Pachymetry: 522 µm: 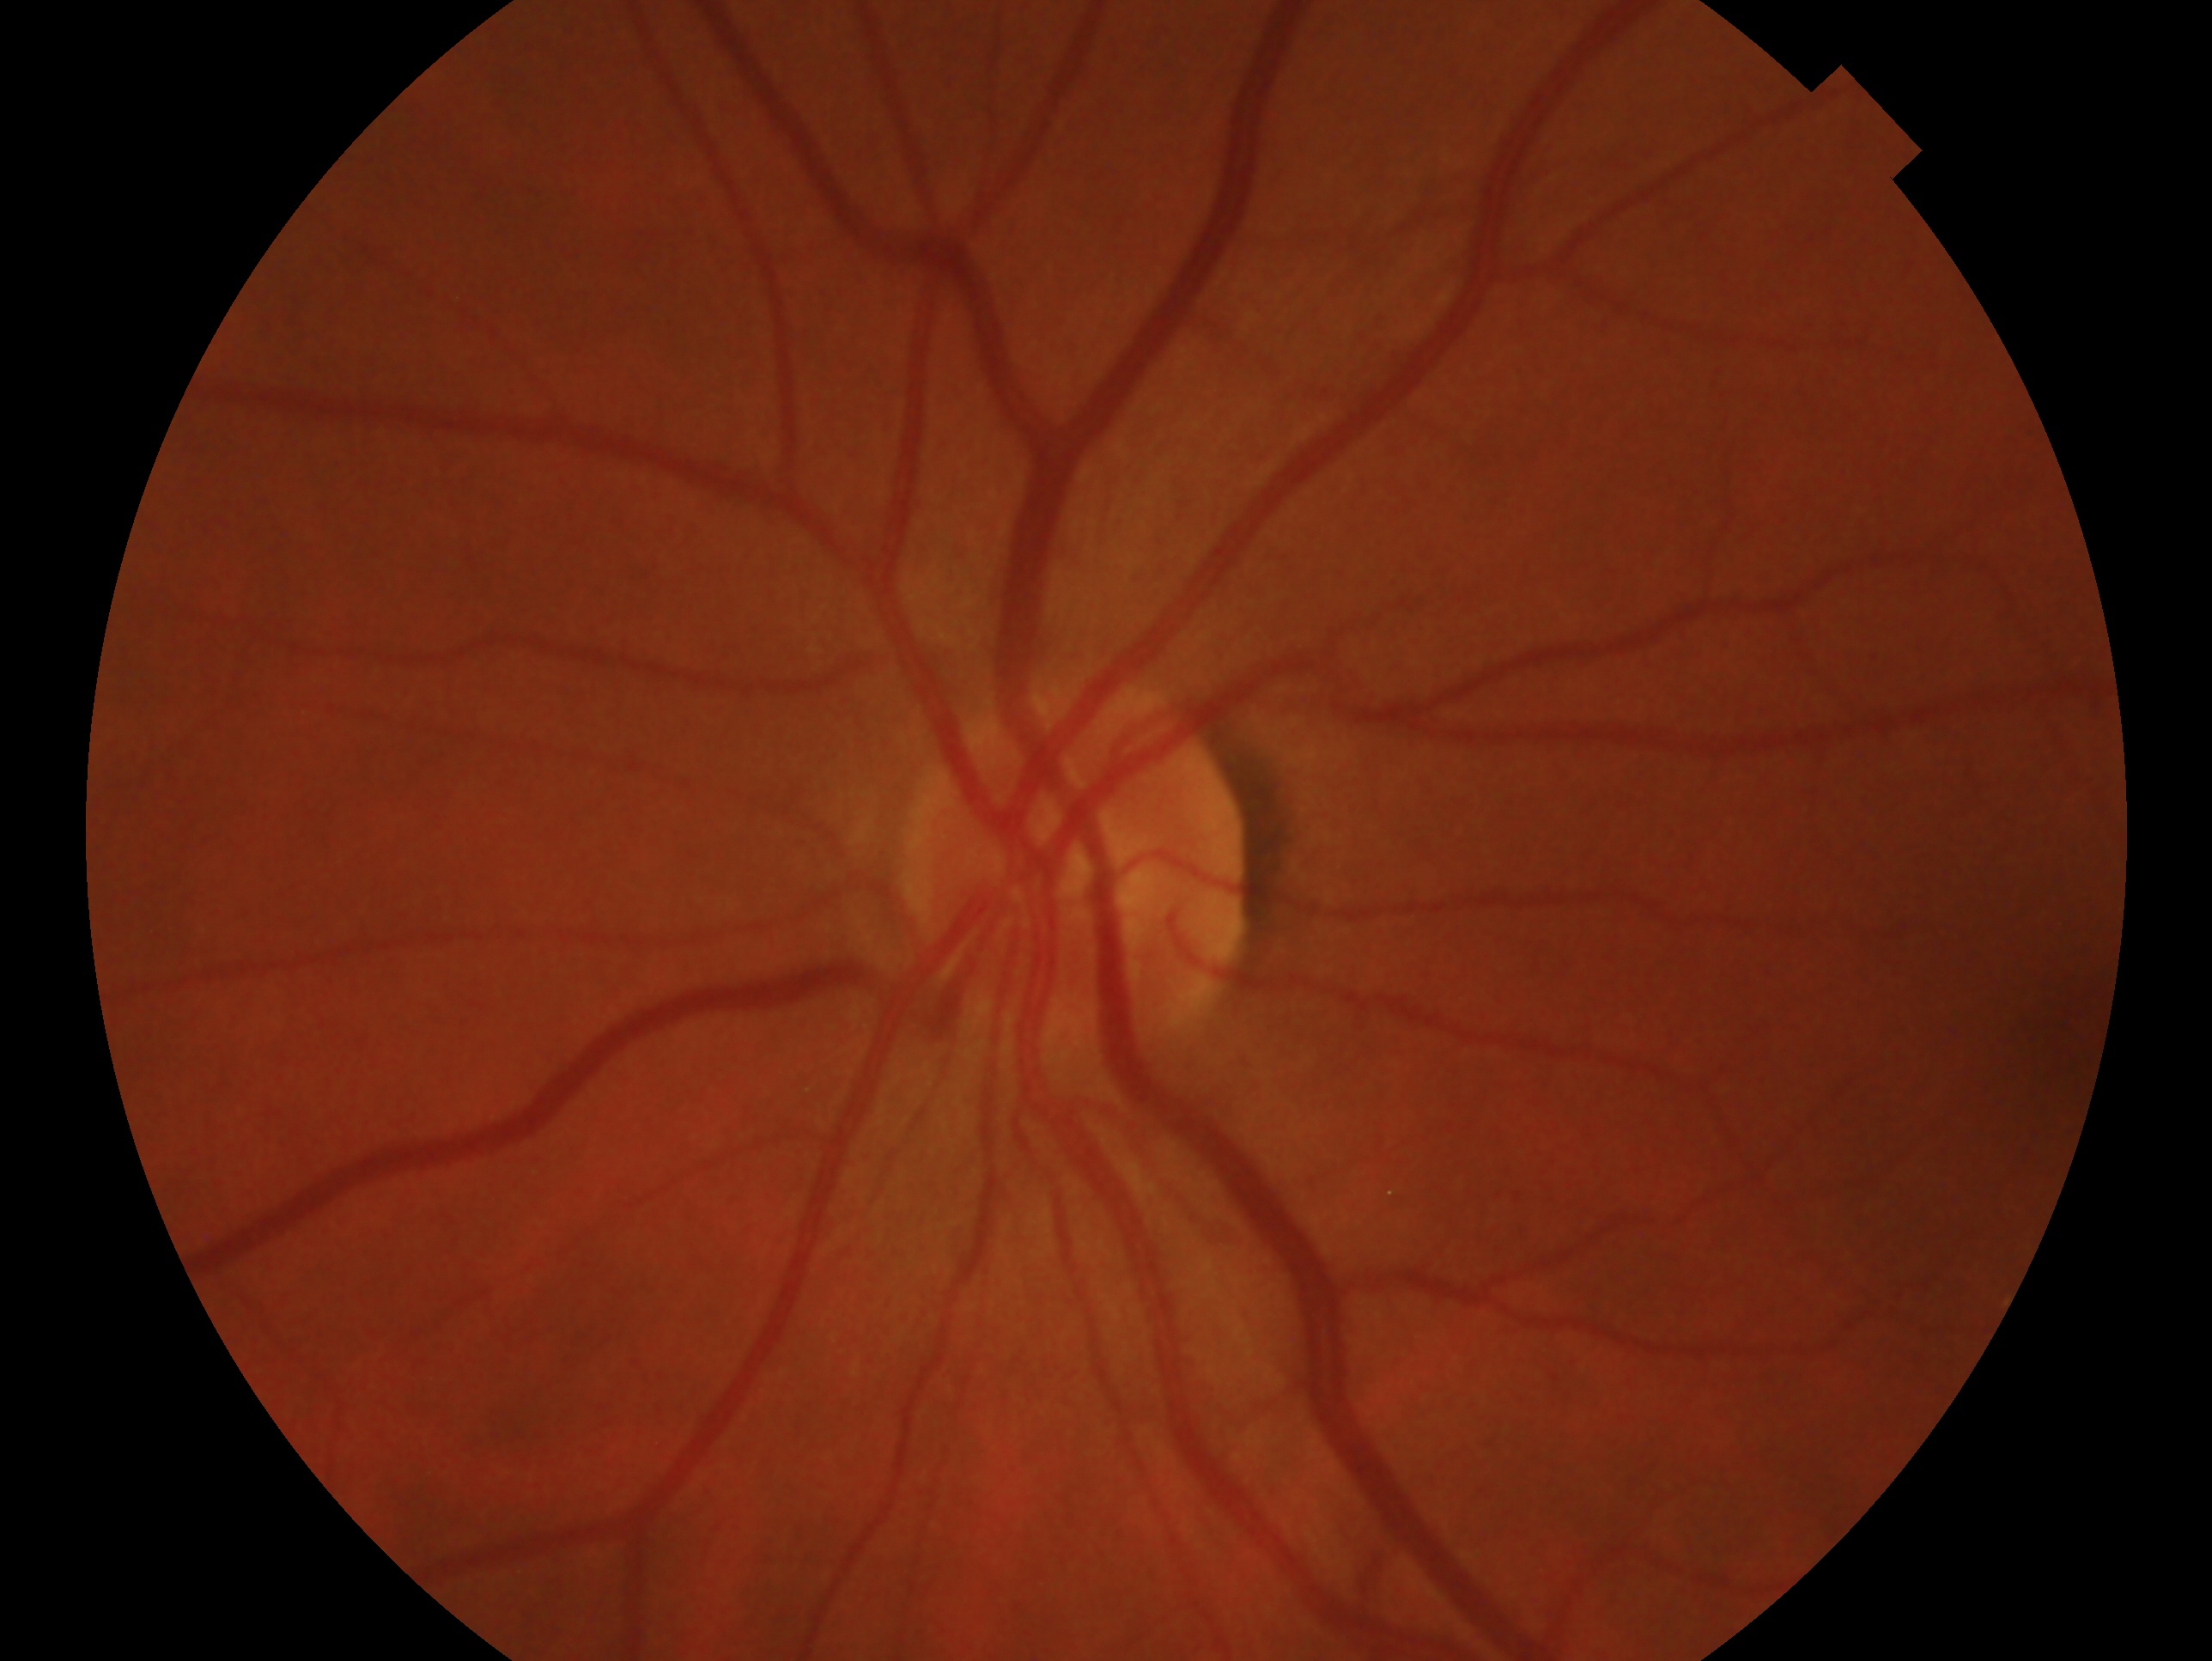

The image shows the left eye. Diagnosis: no glaucoma — no clinical evidence of glaucoma in this eye.